848x848px · without pupil dilation · fundus photo · 45-degree field of view.
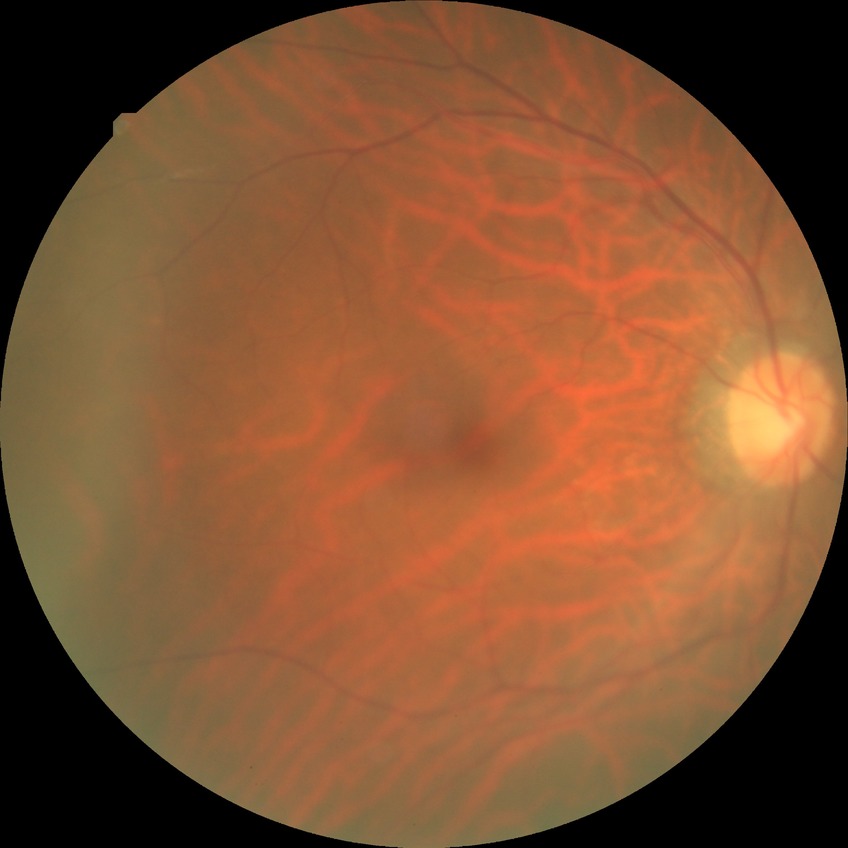

Davis DR grade is NDR.